FOV: 45 degrees, retinal fundus photograph
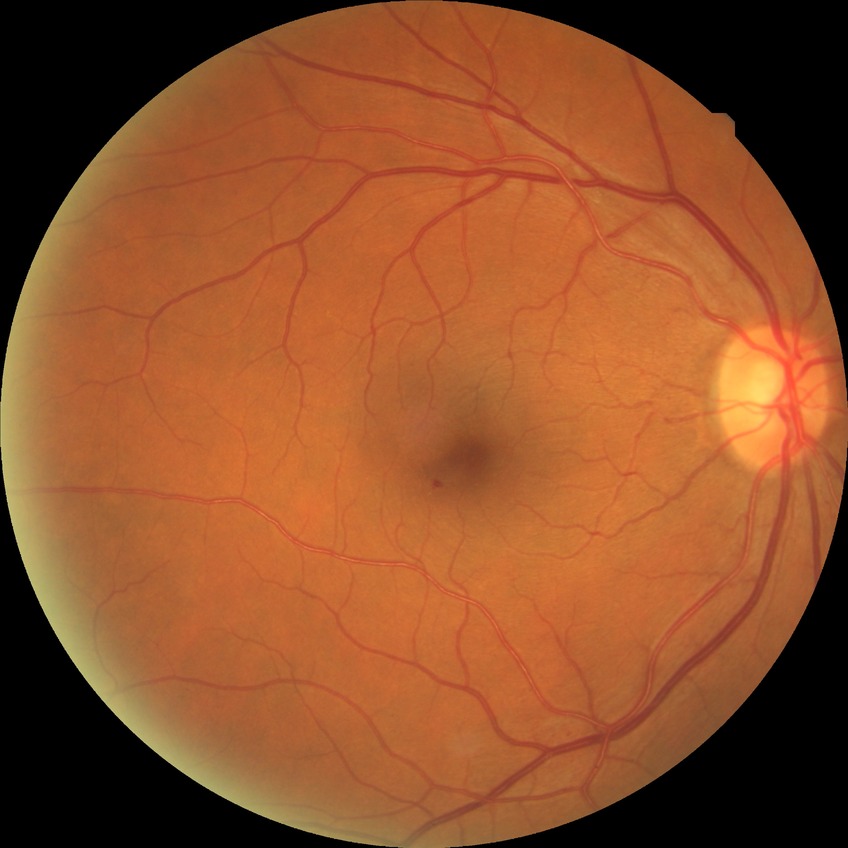 Diabetic retinopathy (DR) is NDR (no diabetic retinopathy).